45-degree field of view, fundus photo — 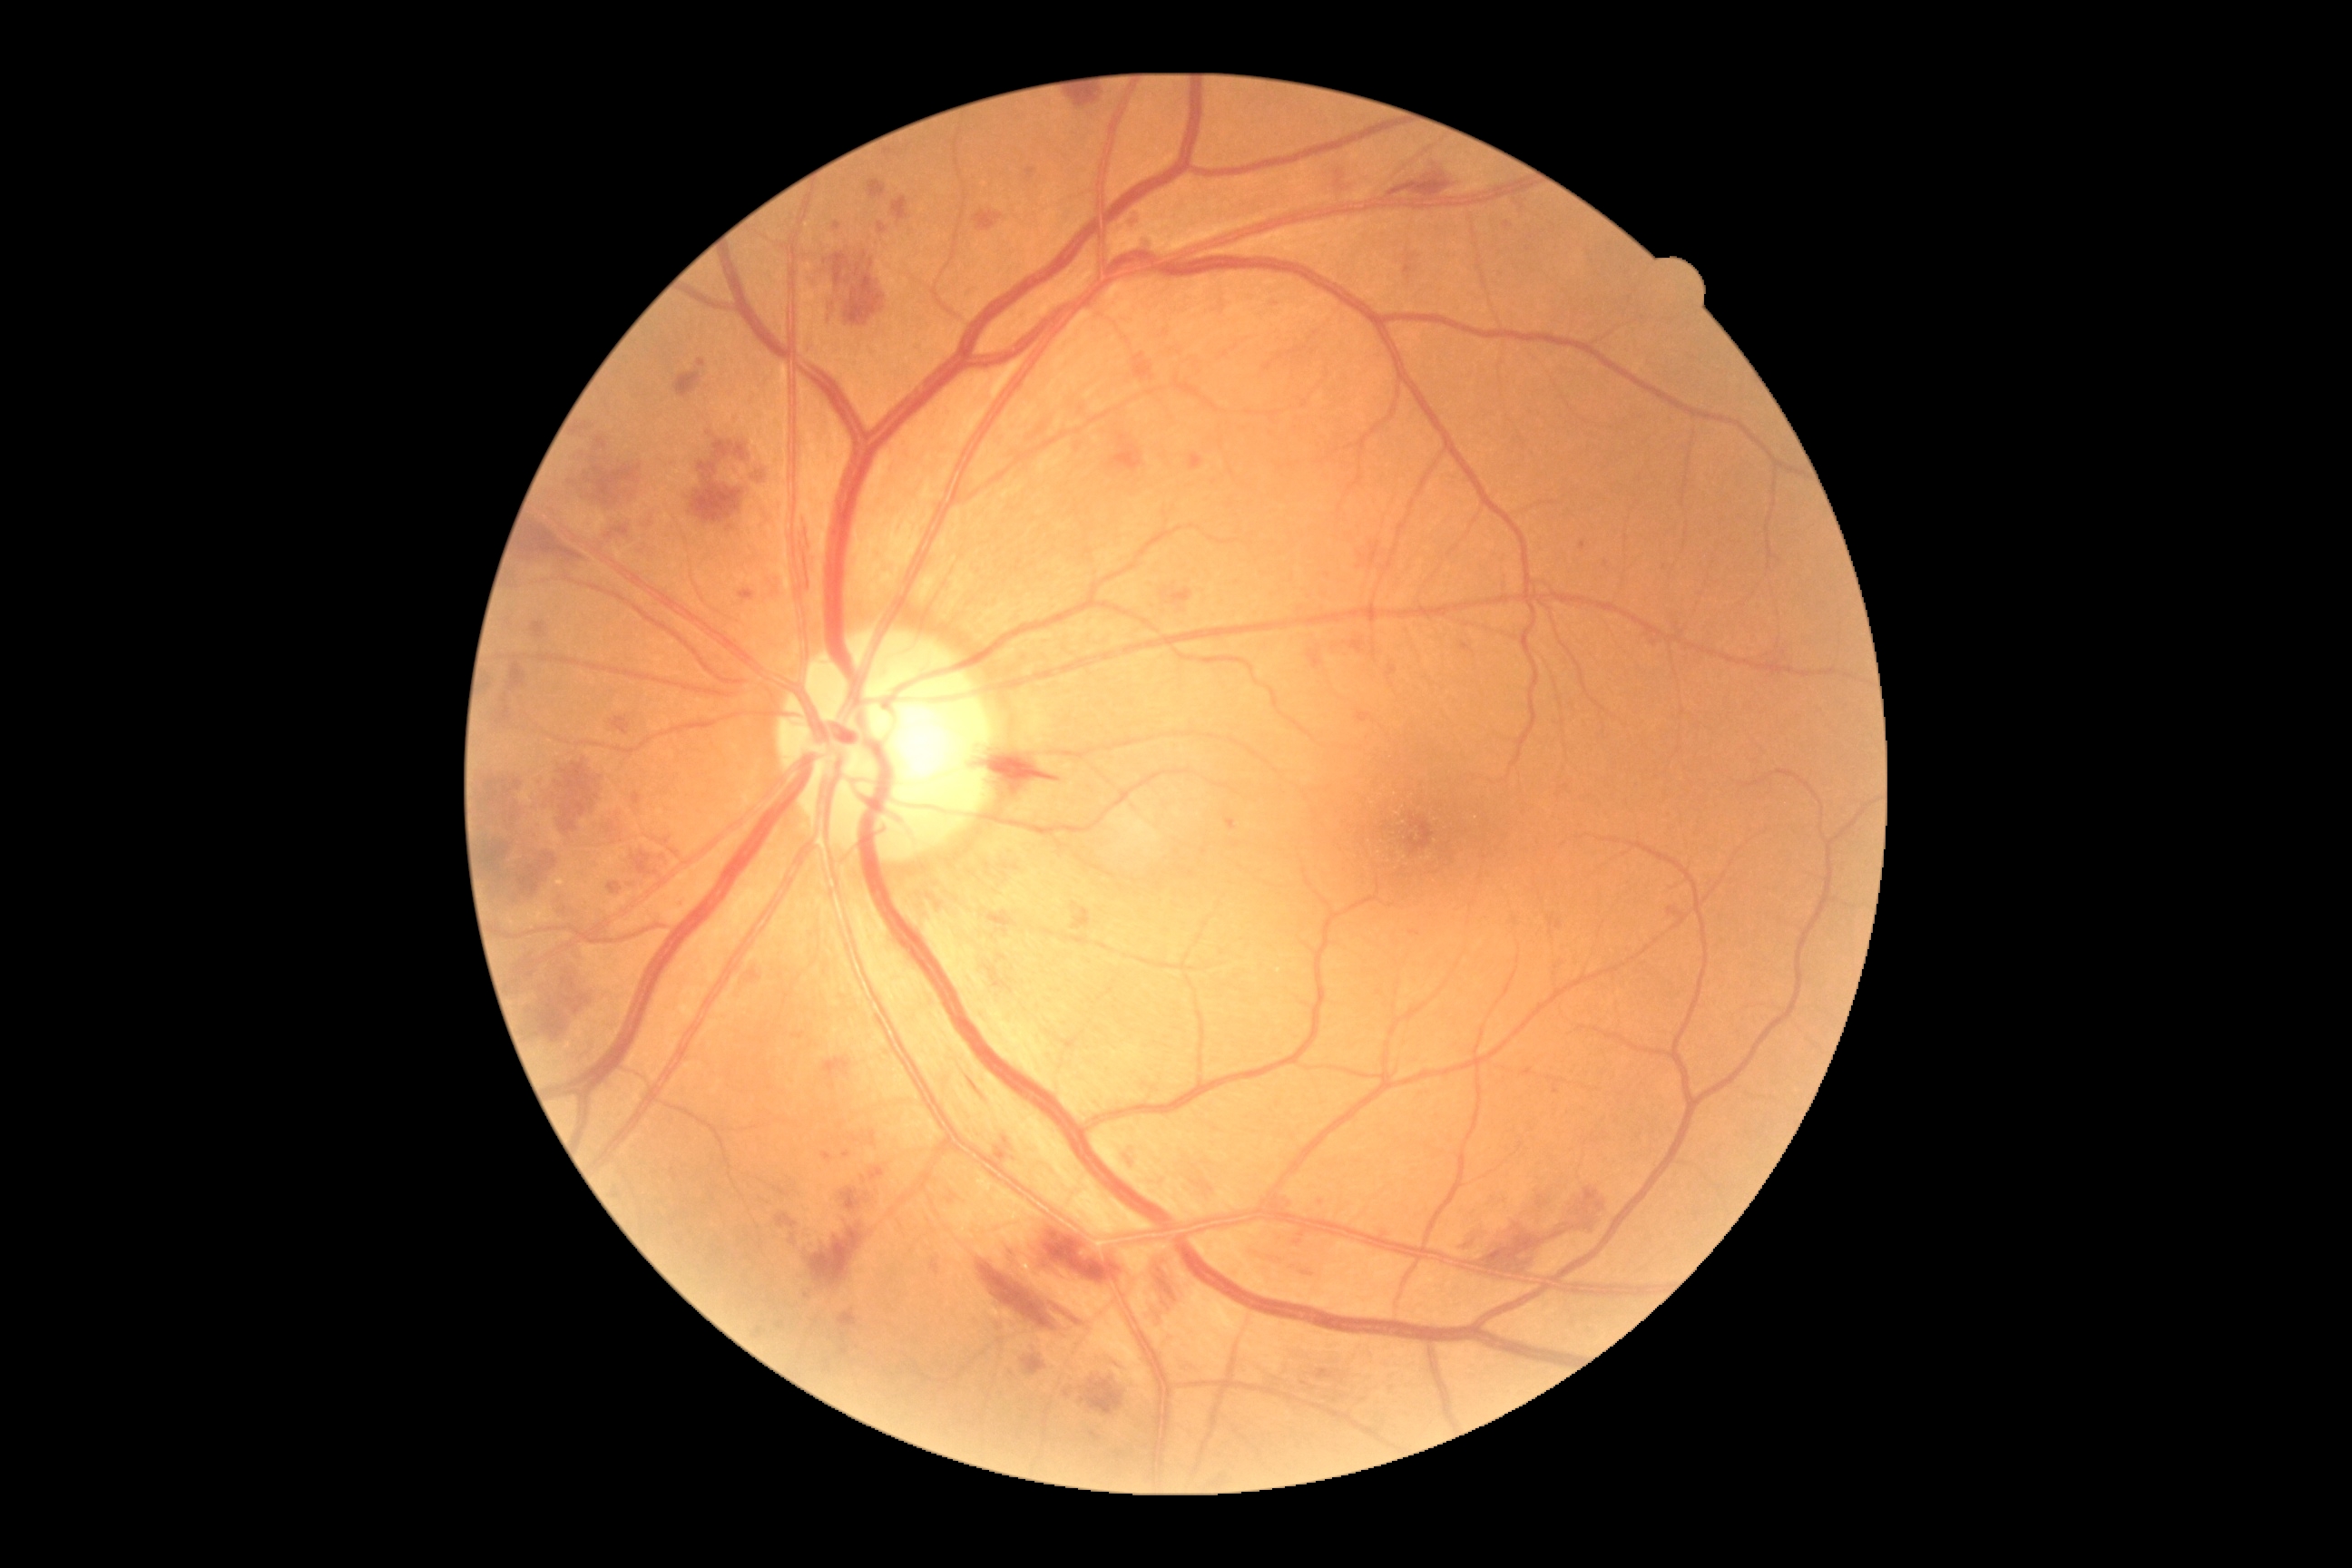
Diabetic retinopathy (DR) is 3/4.
No hard exudates (EXs) identified.
Microaneurysms (MAs) include those at left=698, top=360, right=707, bottom=368 | left=1462, top=643, right=1475, bottom=654 | left=1465, top=1244, right=1473, bottom=1250 | left=1142, top=237, right=1157, bottom=253 | left=1562, top=785, right=1571, bottom=790 | left=1284, top=1199, right=1289, bottom=1210 | left=834, top=222, right=841, bottom=231 | left=879, top=222, right=888, bottom=235 | left=1553, top=1086, right=1560, bottom=1095 | left=1404, top=255, right=1420, bottom=280 | left=1357, top=710, right=1371, bottom=723 | left=576, top=422, right=589, bottom=435 | left=749, top=970, right=761, bottom=981 | left=823, top=1153, right=832, bottom=1162 | left=1124, top=1157, right=1132, bottom=1168.
MAs (small, approximate centers) near [x=709, y=433] | [x=806, y=1296] | [x=1655, y=644] | [x=846, y=1155].
Hemorrhages (HEs) include those at left=994, top=1137, right=1015, bottom=1164 | left=605, top=520, right=632, bottom=545 | left=520, top=854, right=558, bottom=897 | left=808, top=250, right=888, bottom=328 | left=1188, top=1175, right=1219, bottom=1204 | left=752, top=462, right=770, bottom=487 | left=1142, top=237, right=1155, bottom=253 | left=1551, top=1186, right=1609, bottom=1240 | left=1072, top=908, right=1092, bottom=930 | left=520, top=524, right=589, bottom=565 | left=1190, top=453, right=1204, bottom=471 | left=868, top=181, right=887, bottom=199 | left=642, top=513, right=658, bottom=531 | left=1171, top=587, right=1193, bottom=605 | left=974, top=211, right=1004, bottom=231 | left=564, top=451, right=642, bottom=516.
No soft exudates (SEs) identified.